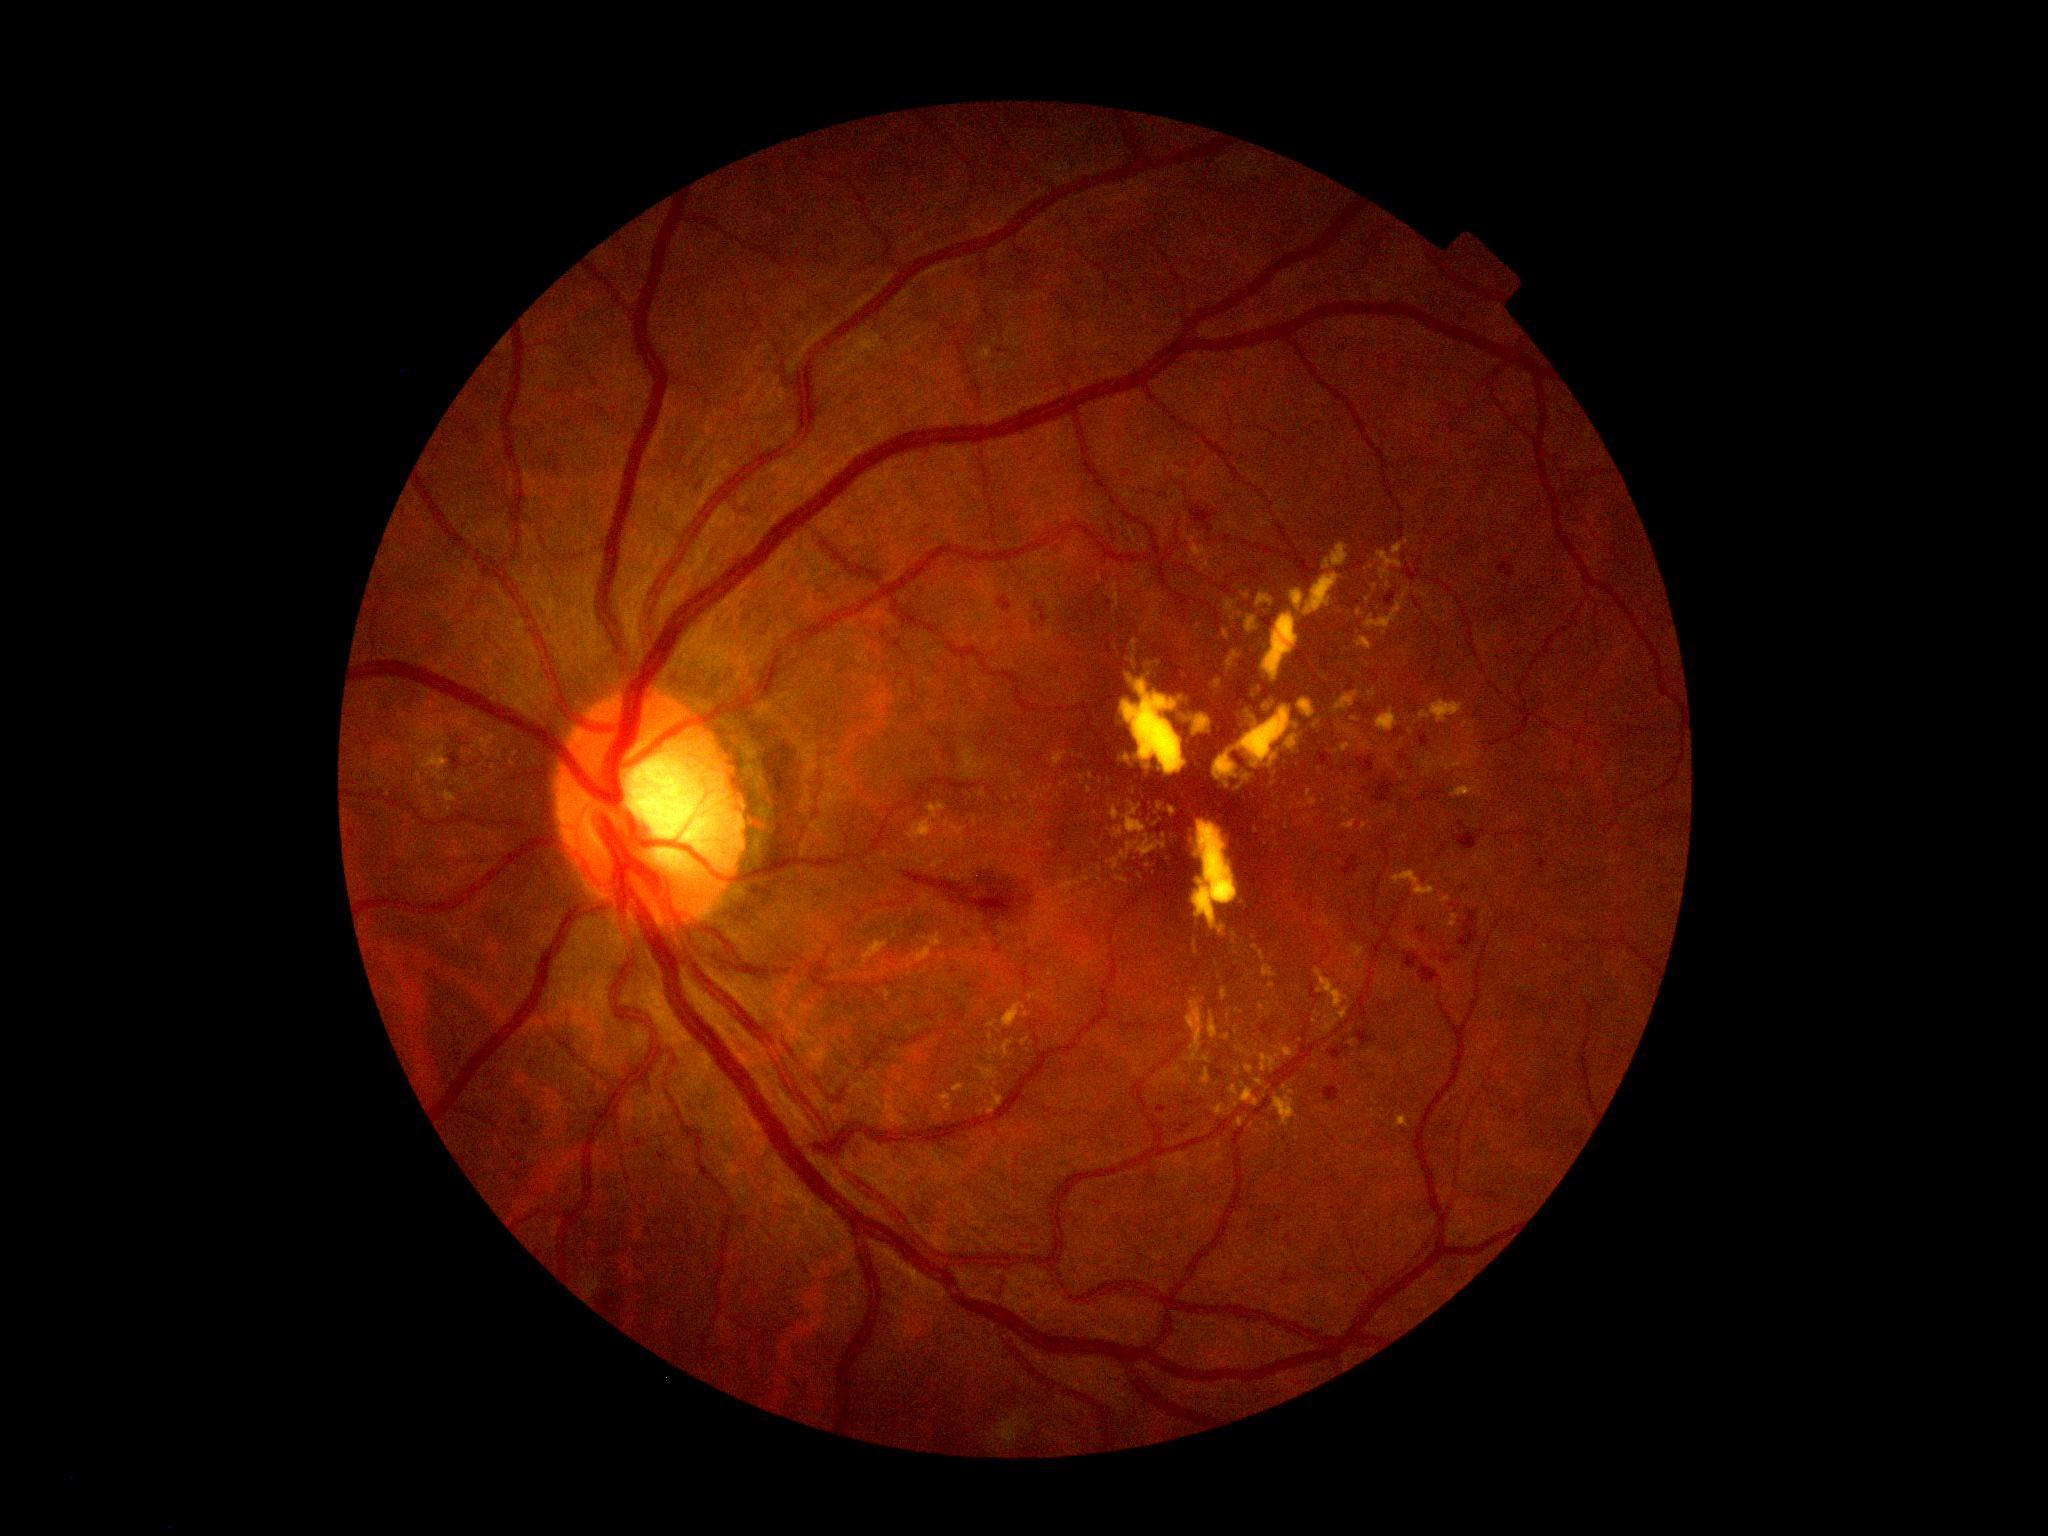

Retinopathy grade is 2 (moderate NPDR). Disease class: non-proliferative diabetic retinopathy.